Wide-field fundus photograph from neonatal ROP screening
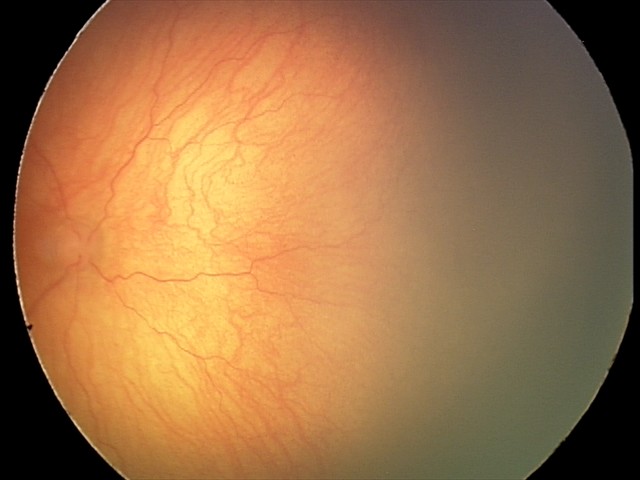

Screening series with aggressive ROP (A-ROP). Plus disease present.